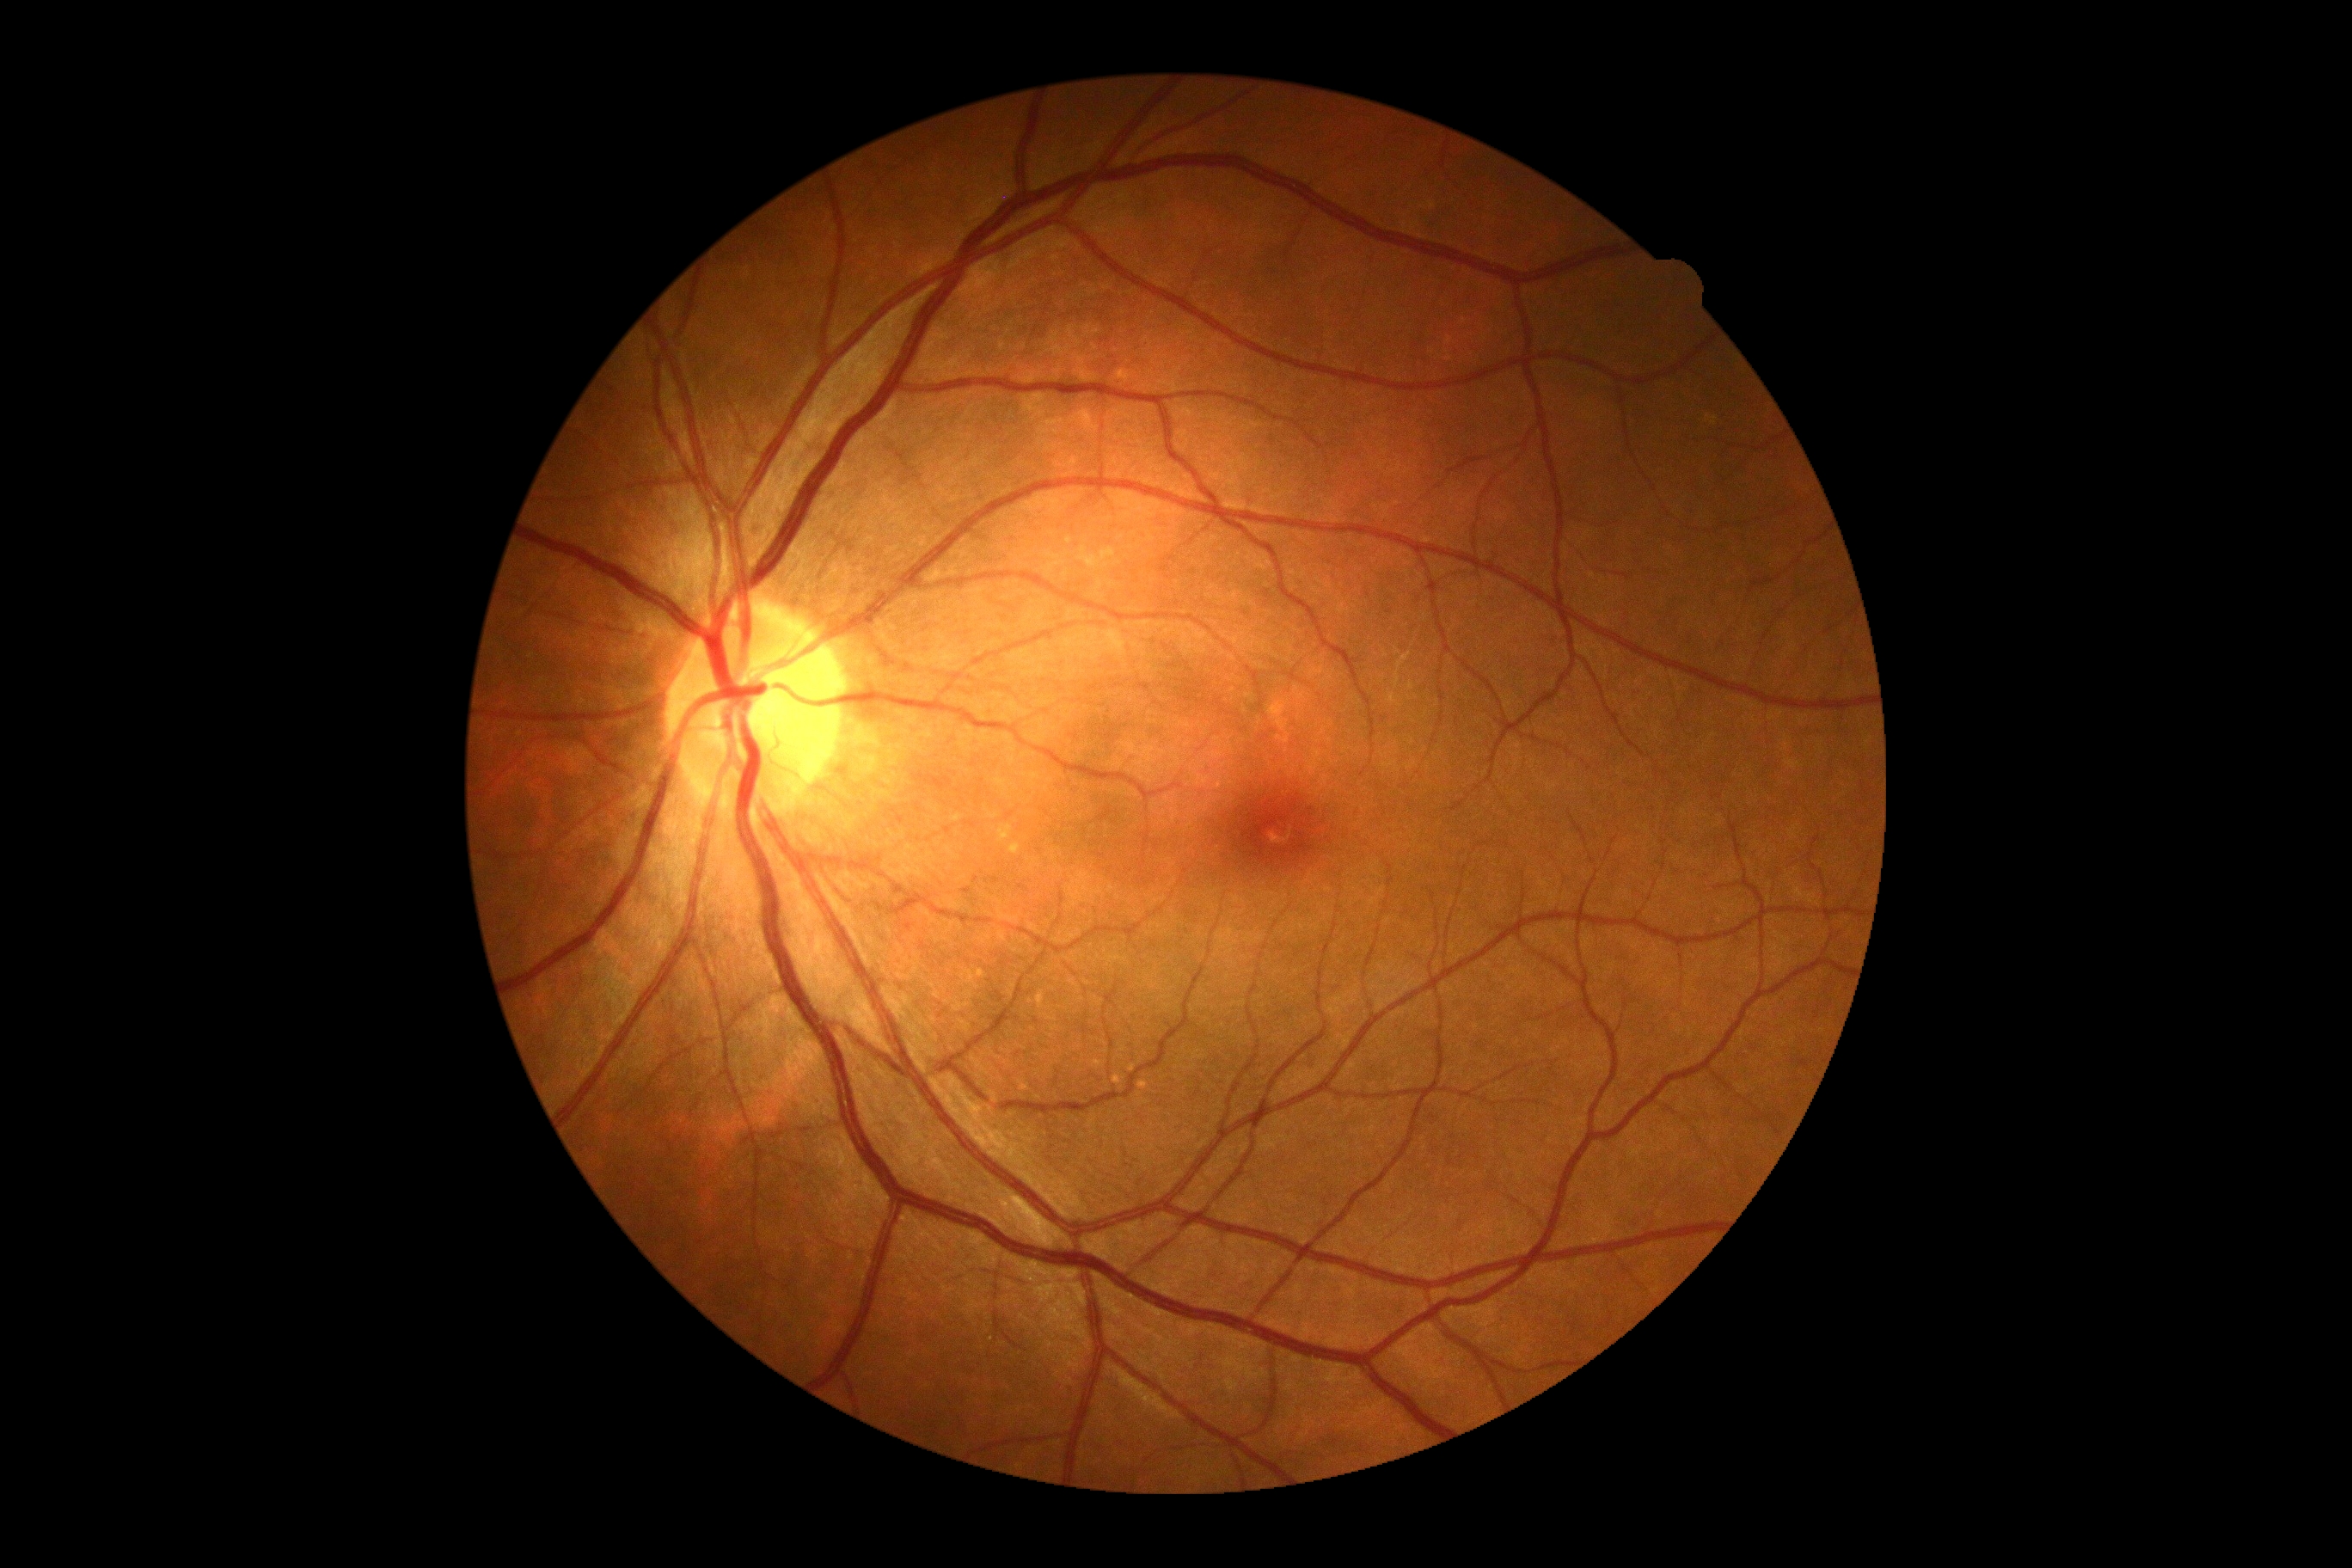 No diabetic retinal disease findings.
Diabetic retinopathy (DR) is no apparent diabetic retinopathy (grade 0).